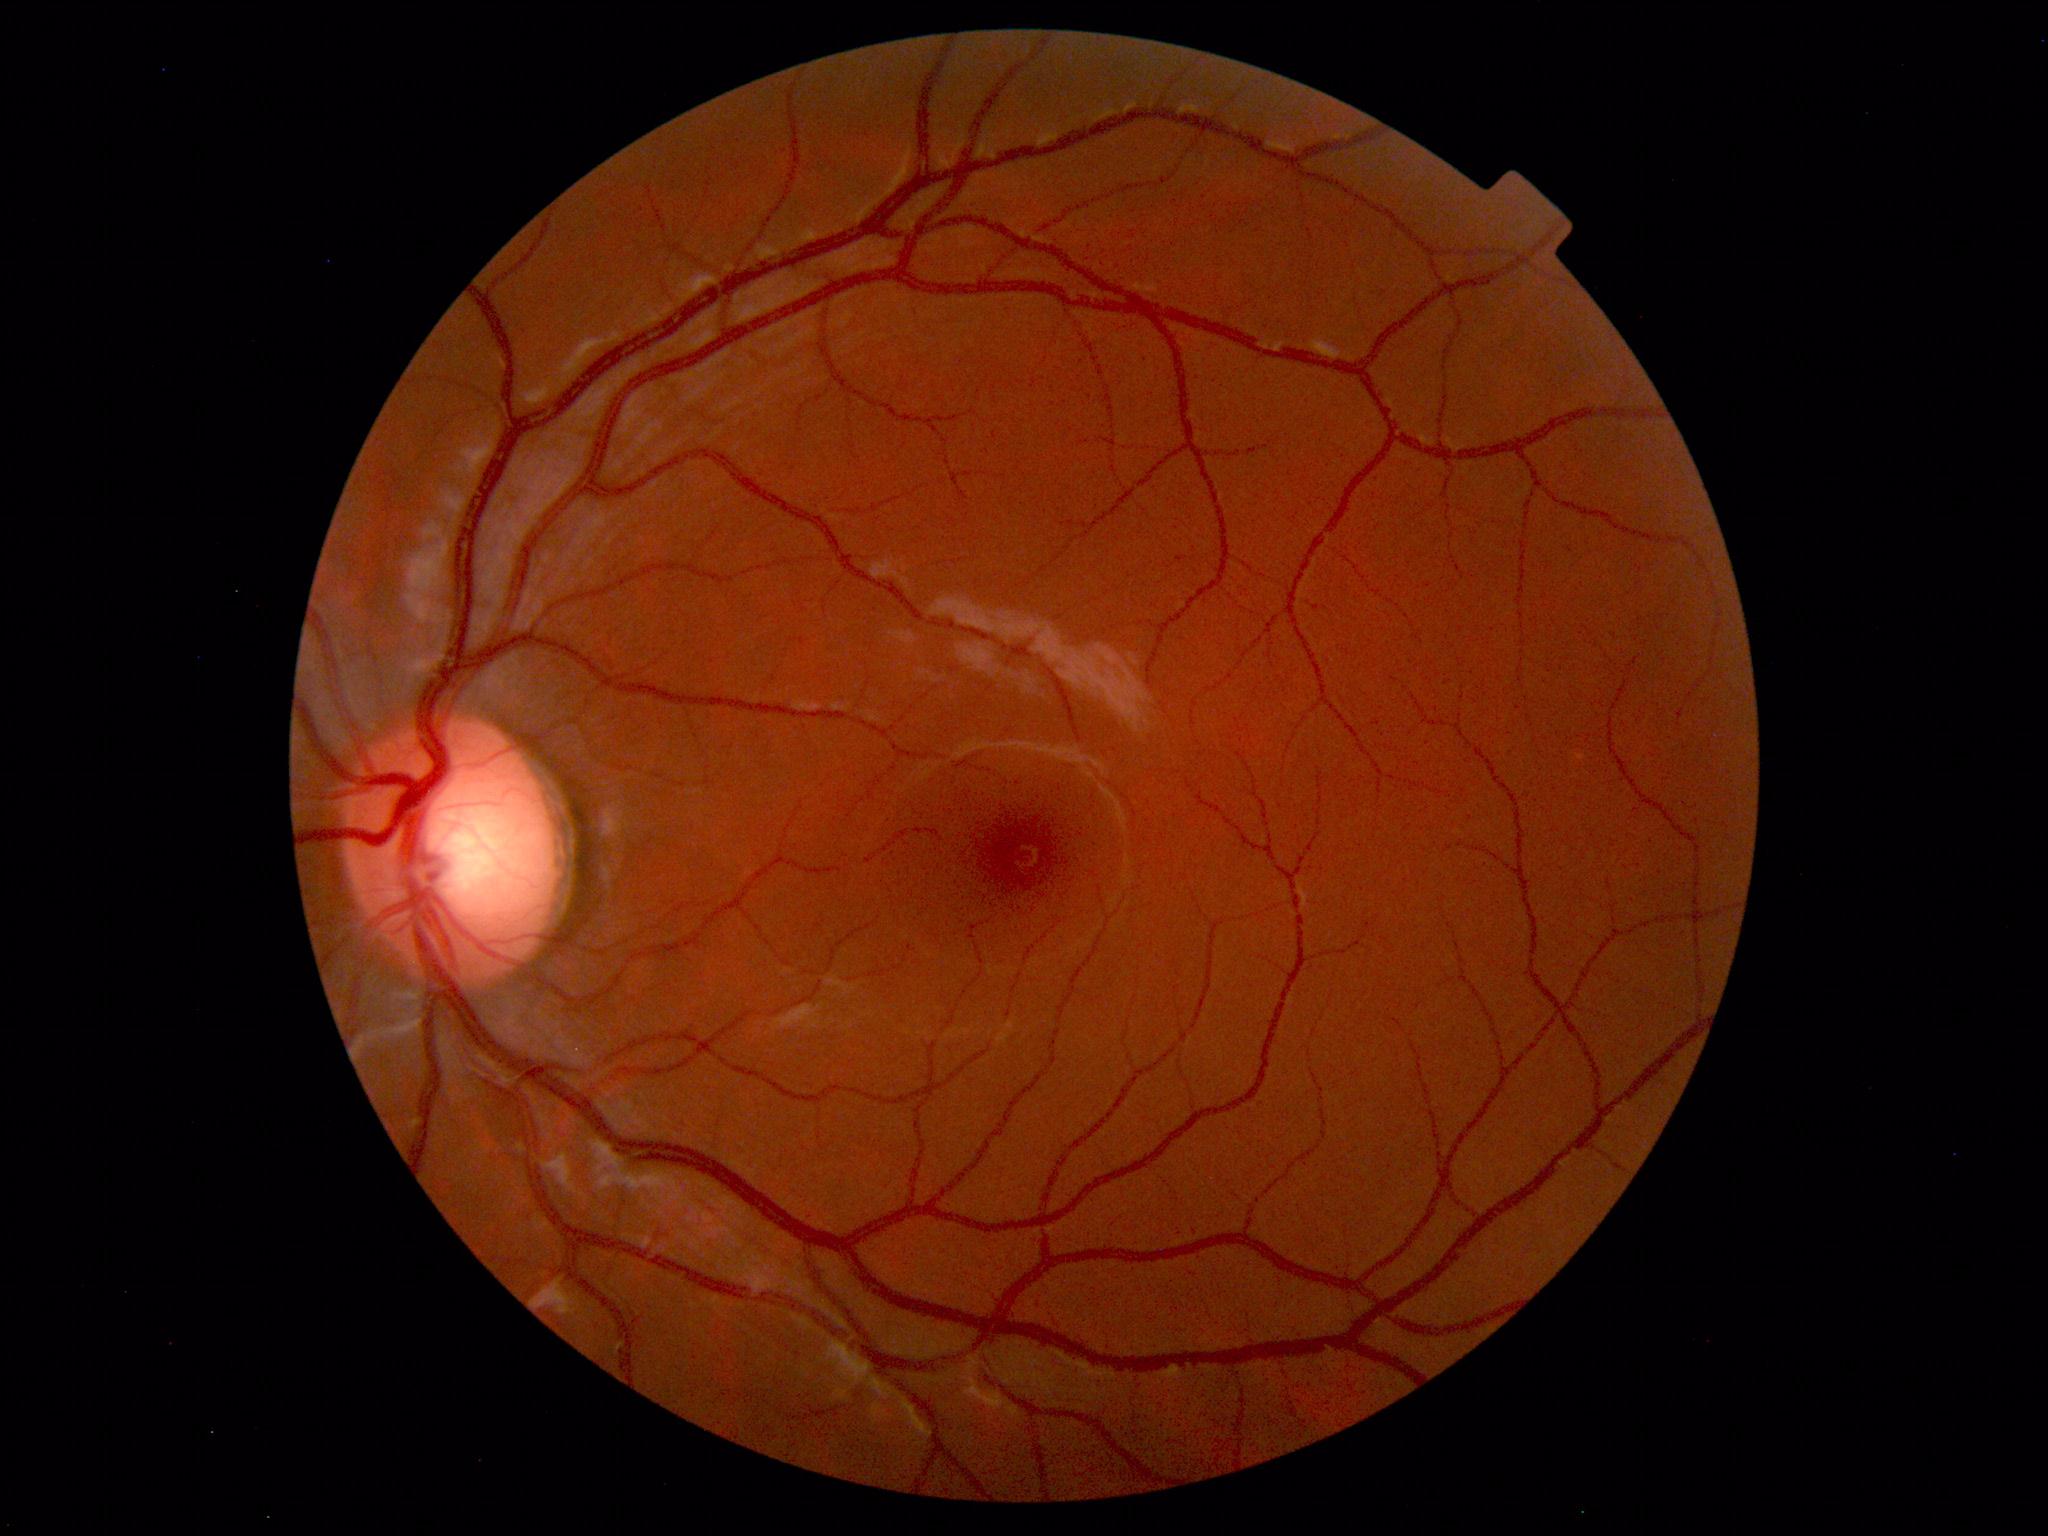
Normal retinal fundus image with no abnormalities identified.